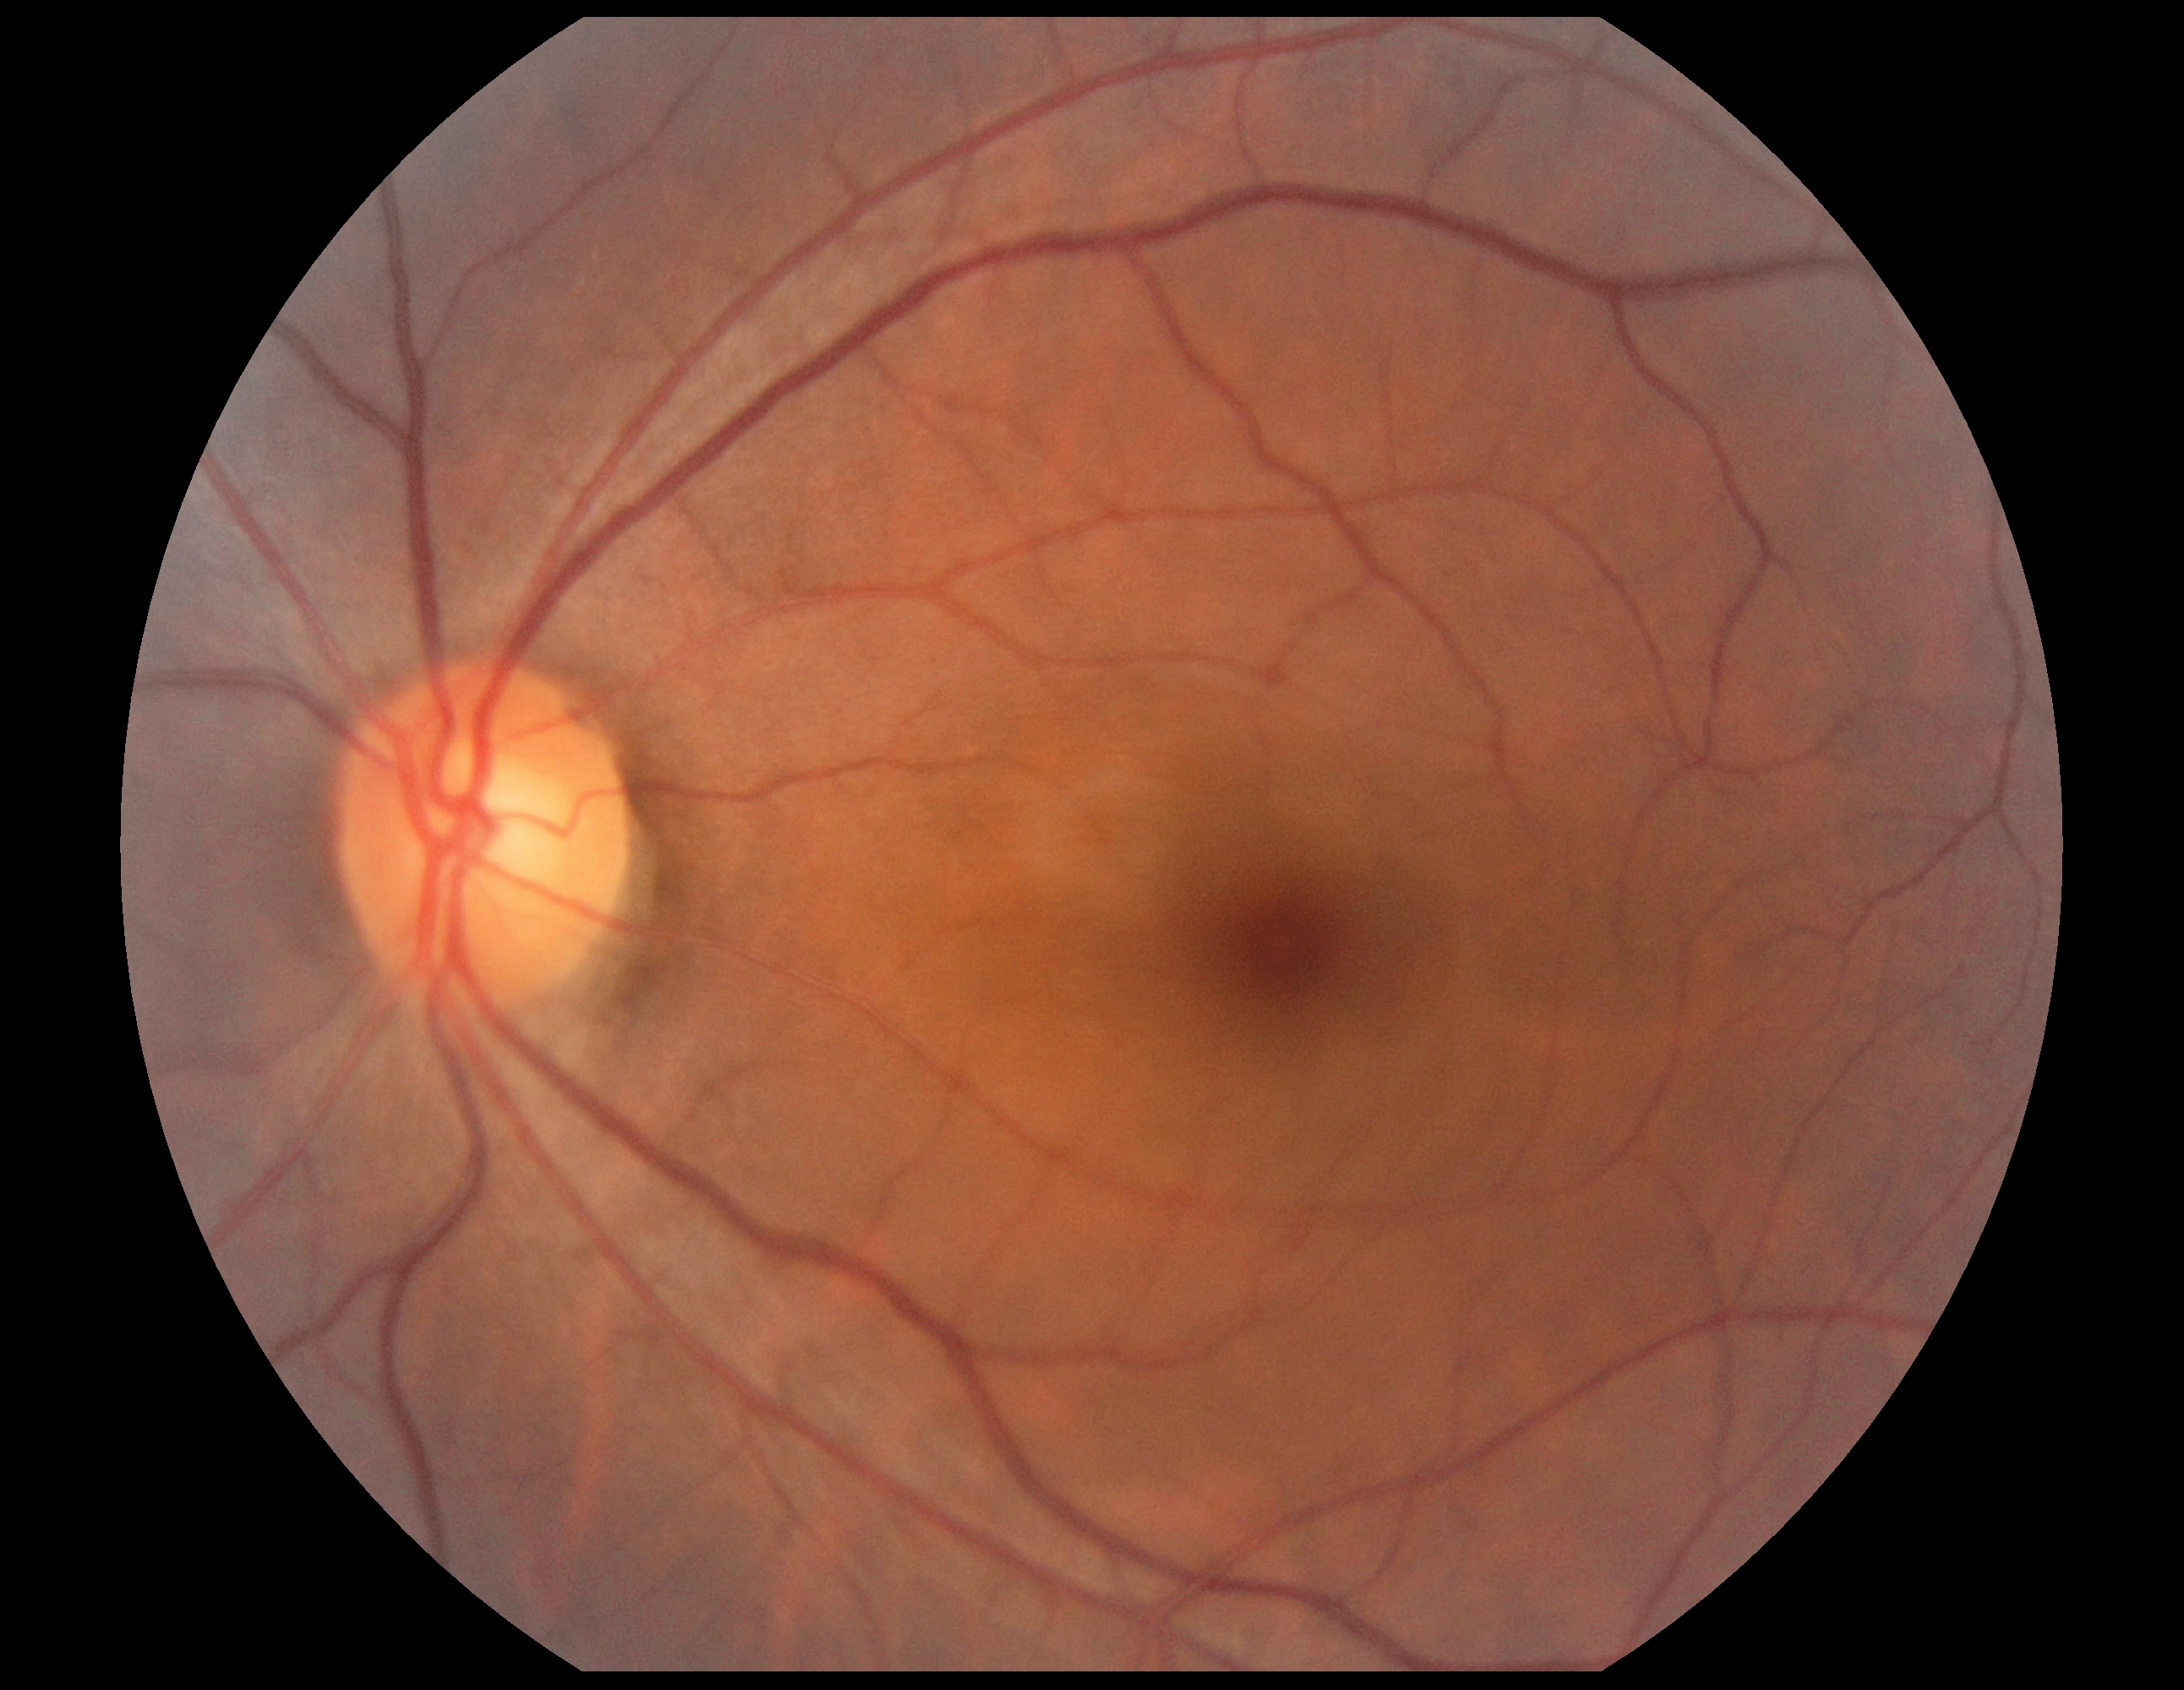
{"dr_impression": "no apparent DR", "dr_grade": "0"}